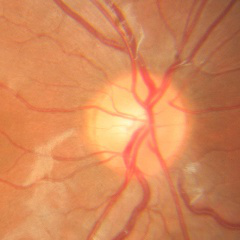
No glaucomatous changes.